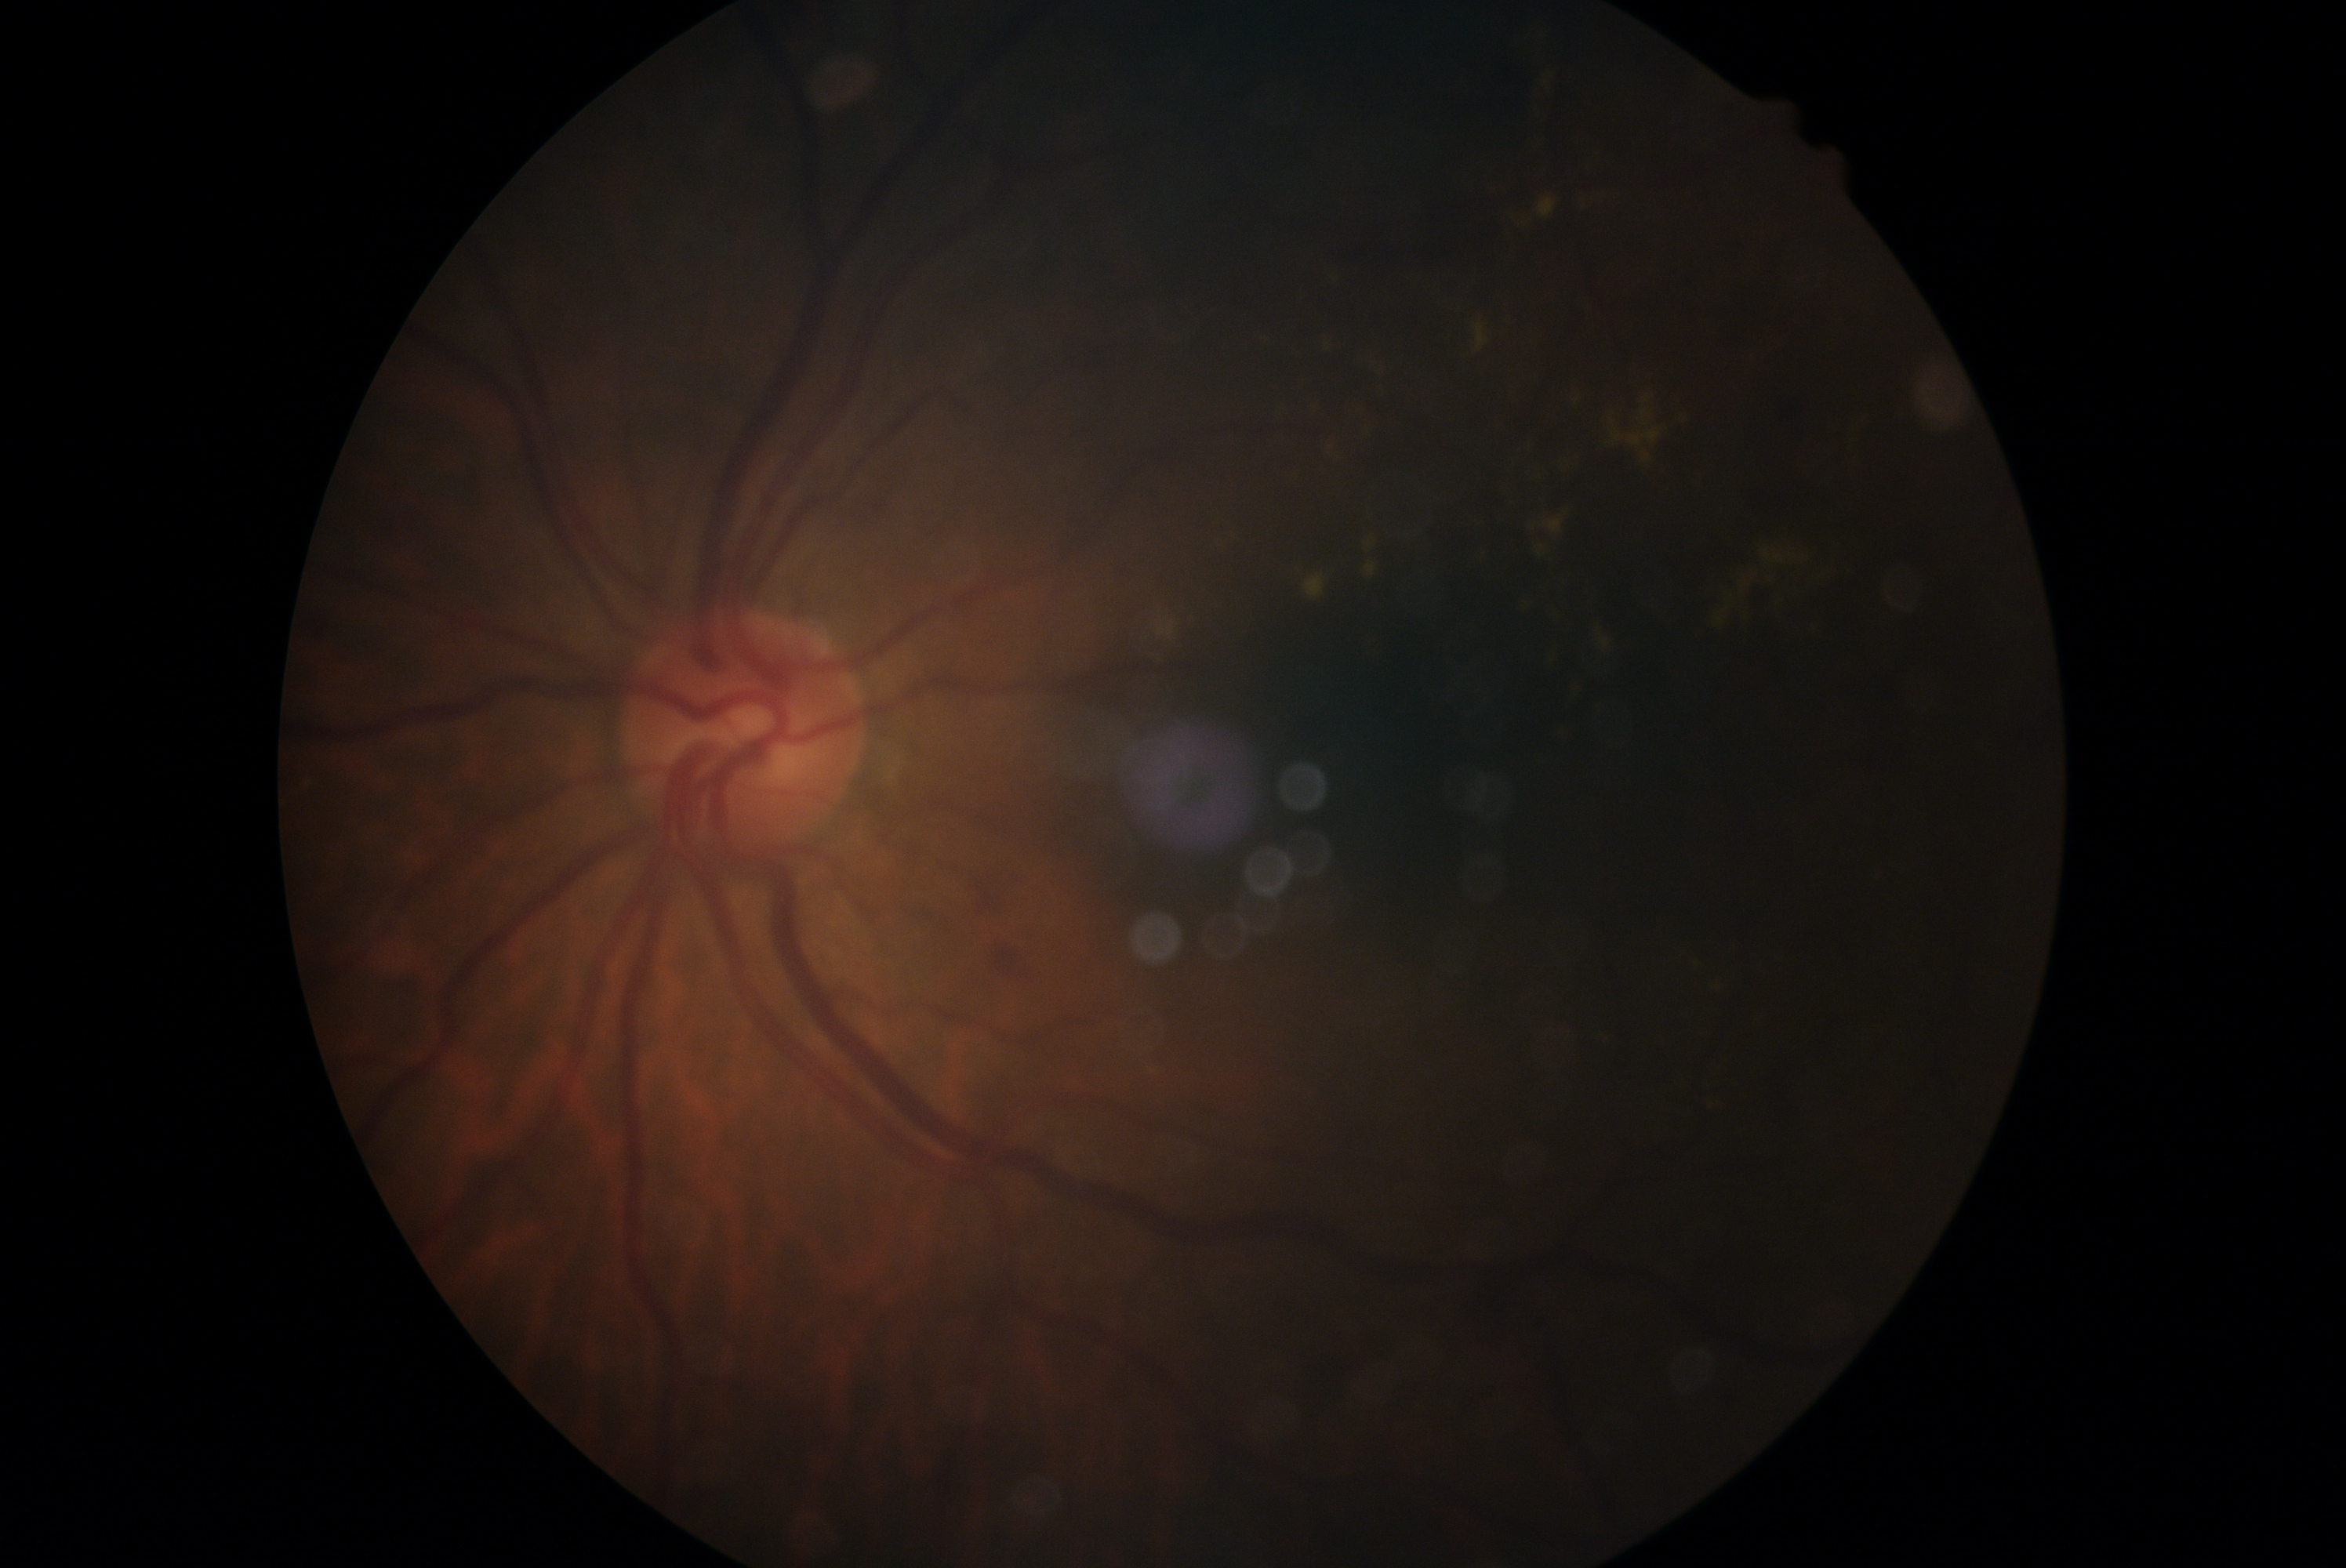

DR class: non-proliferative diabetic retinopathy. Diabetic retinopathy: moderate non-proliferative diabetic retinopathy (grade 2).